NIDEK AFC-230 fundus camera, retinal fundus photograph, modified Davis classification — 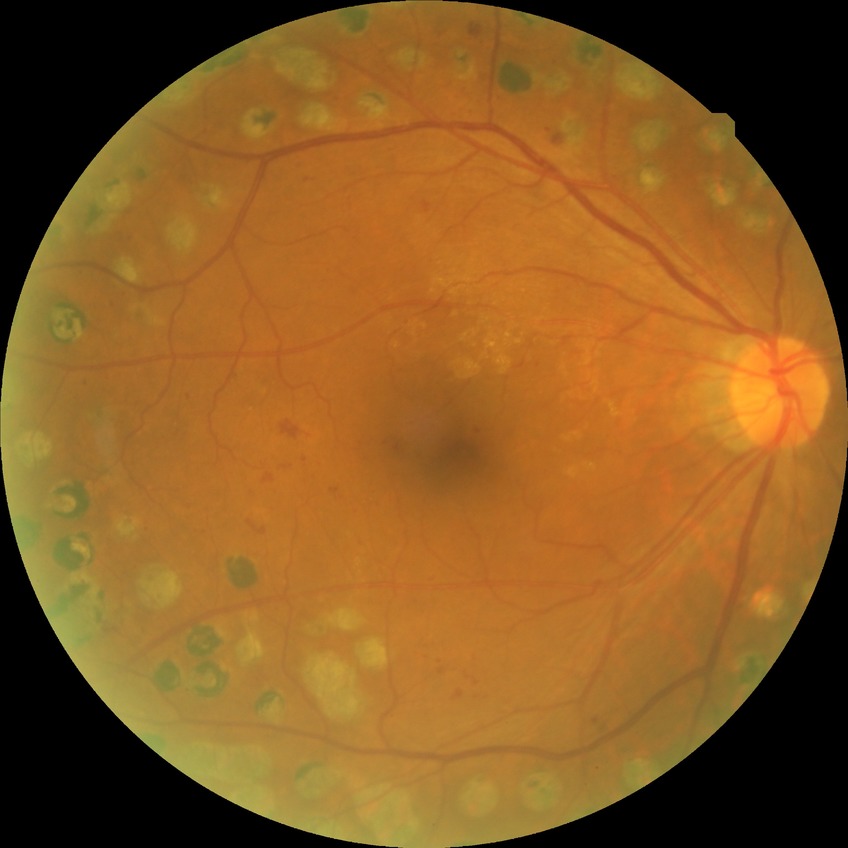
  davis_grade: proliferative diabetic retinopathy